Infant wide-field fundus photograph. Captured with the Natus RetCam Envision (130° field of view): 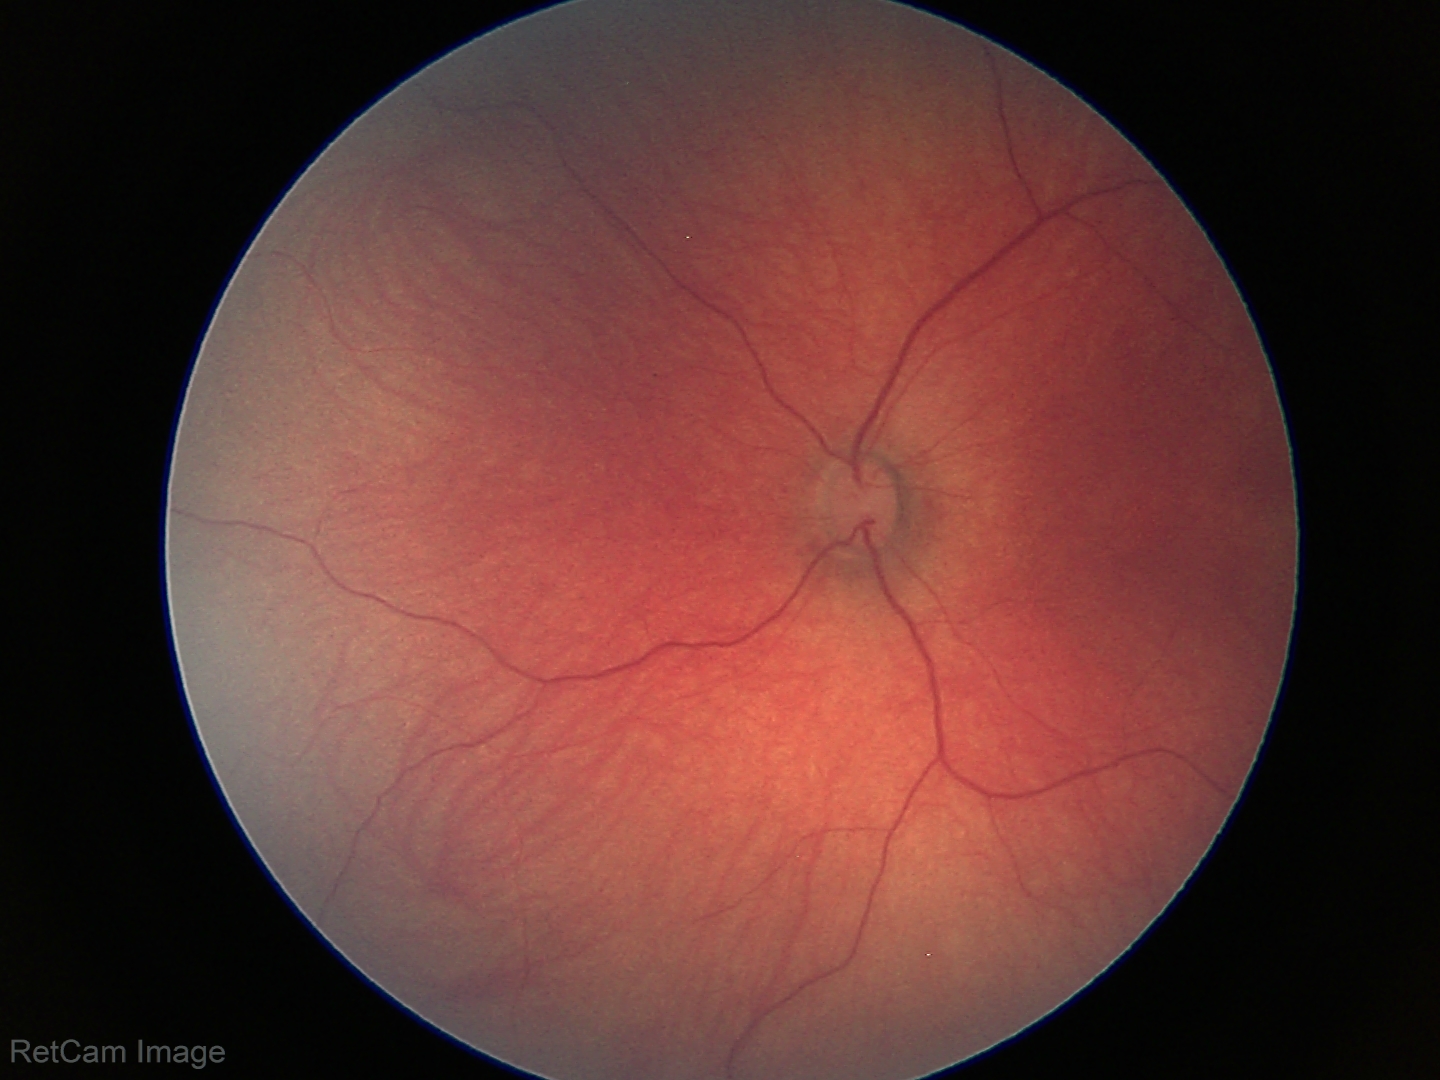 Impression: physiological retinal finding.